Nonmydriatic · posterior pole photograph — 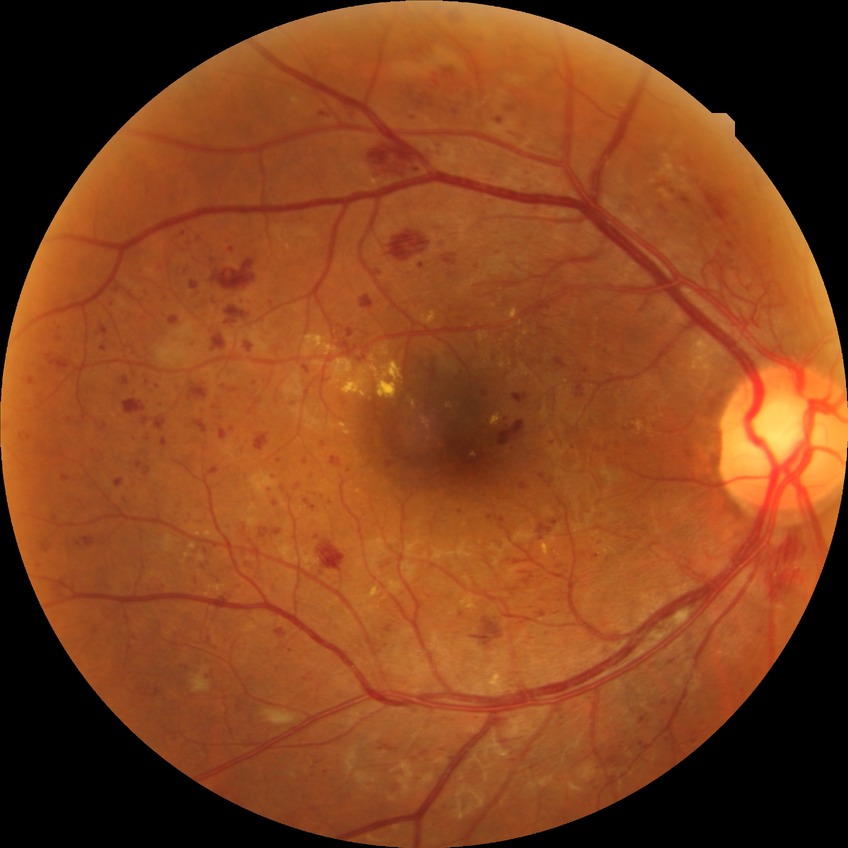 Diabetic retinopathy severity: proliferative diabetic retinopathy.